Color fundus photograph, 2048x1536px, FOV: 45 degrees.
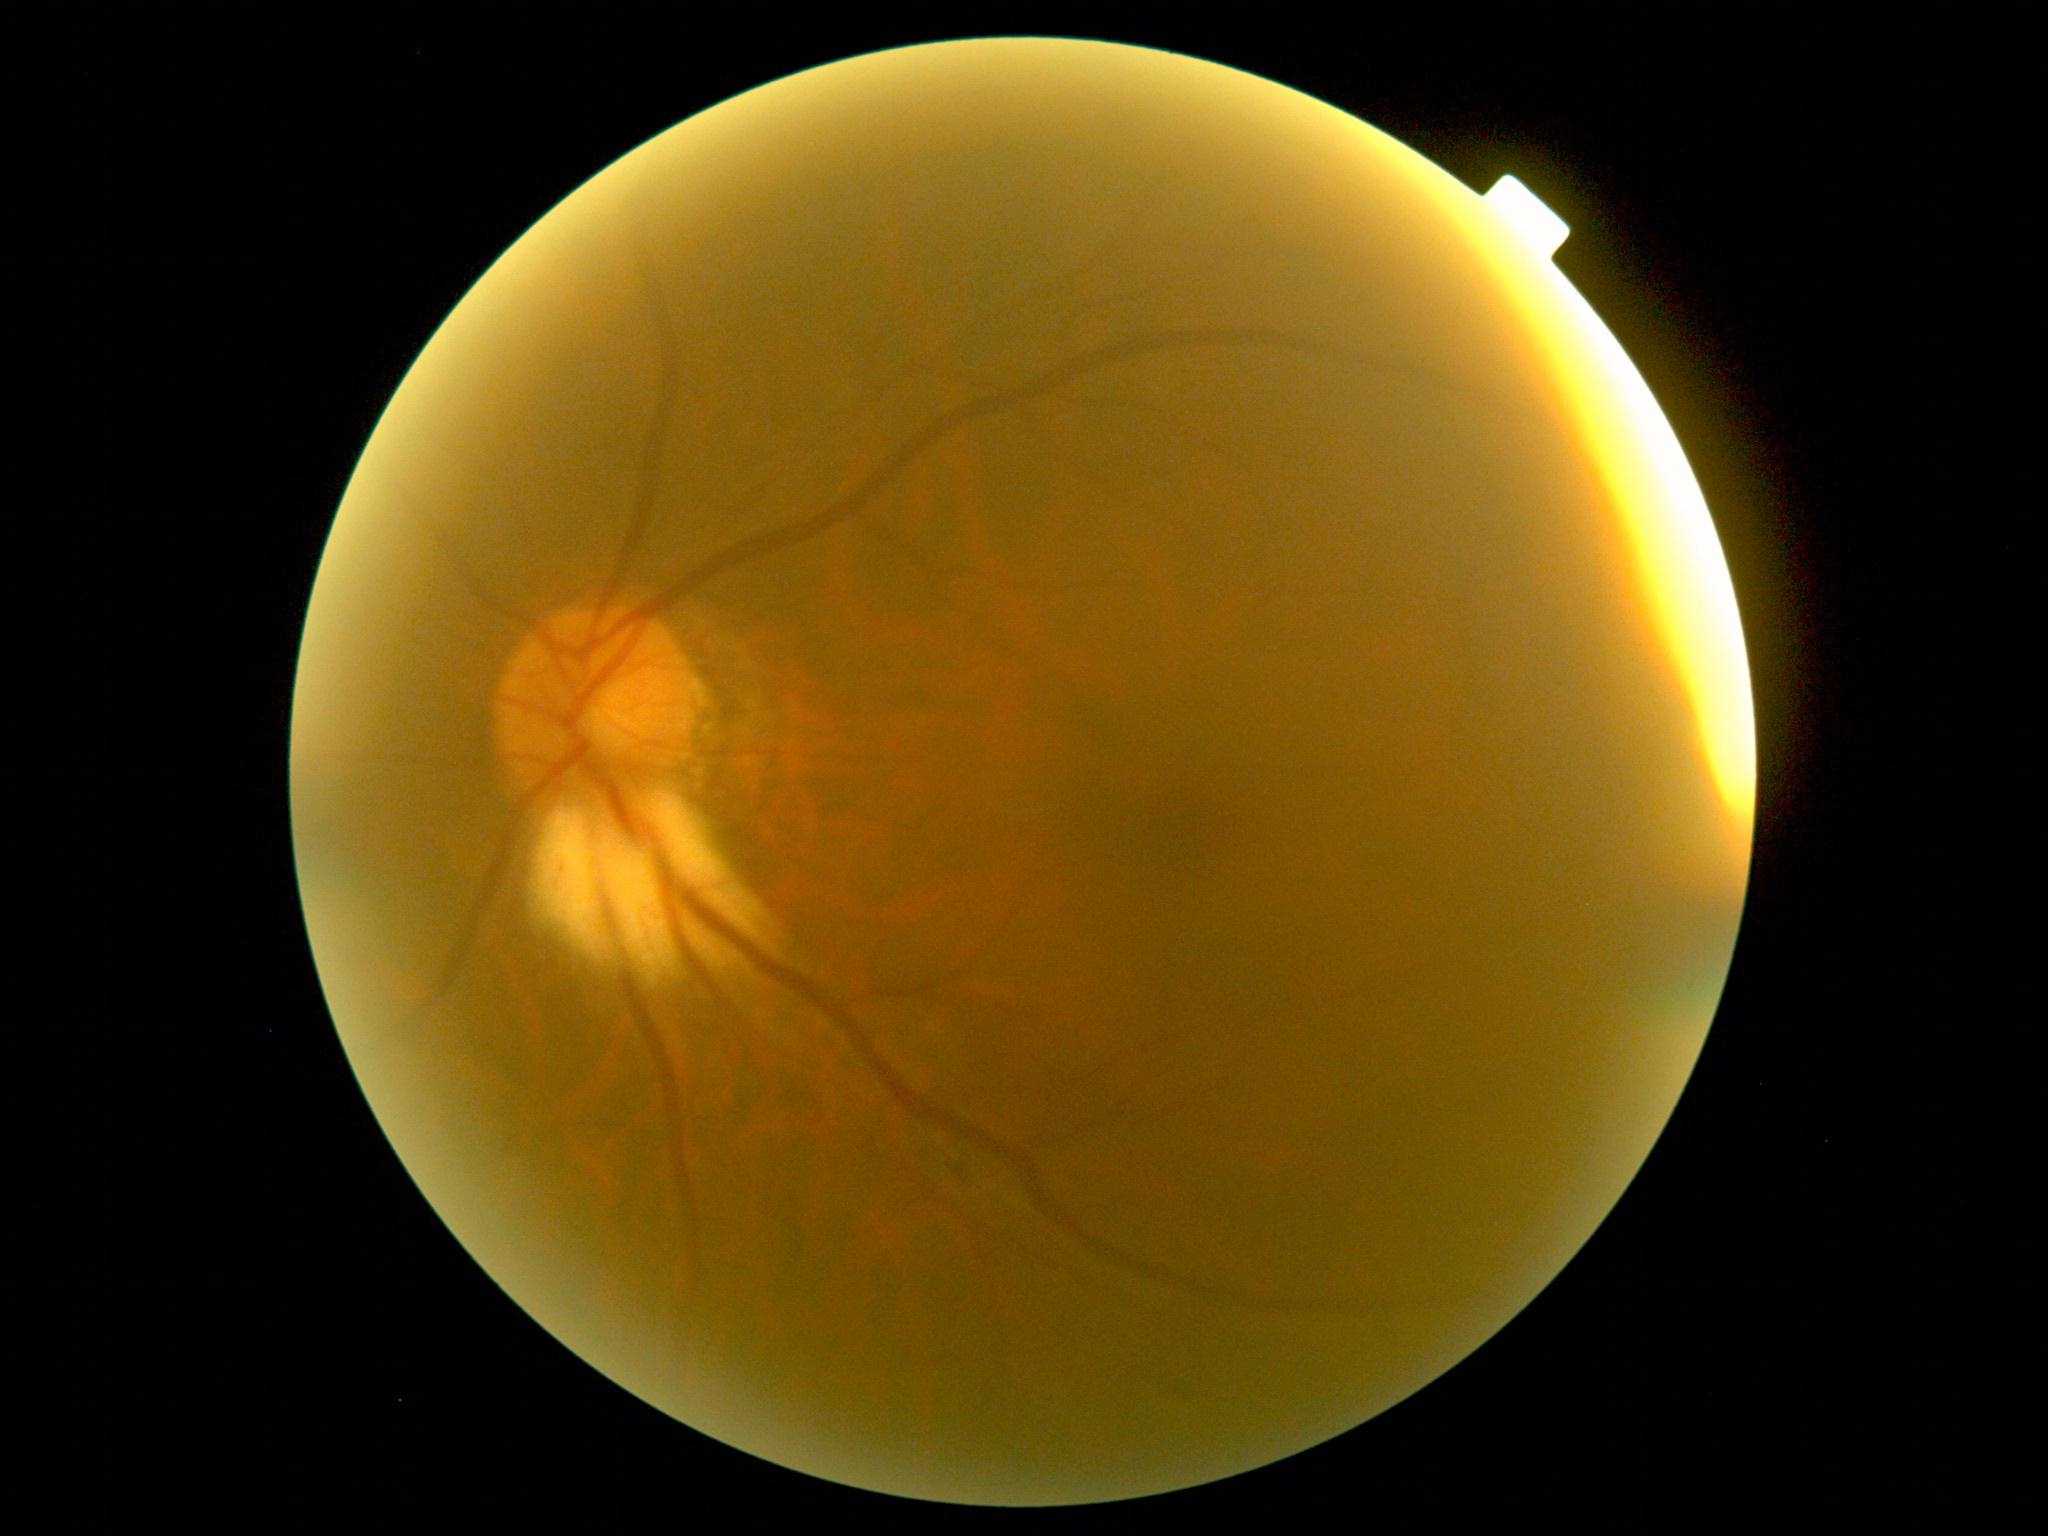

Findings:
- diabetic retinopathy (DR) — grade 2 (moderate NPDR) — more than just microaneurysms but less than severe NPDR